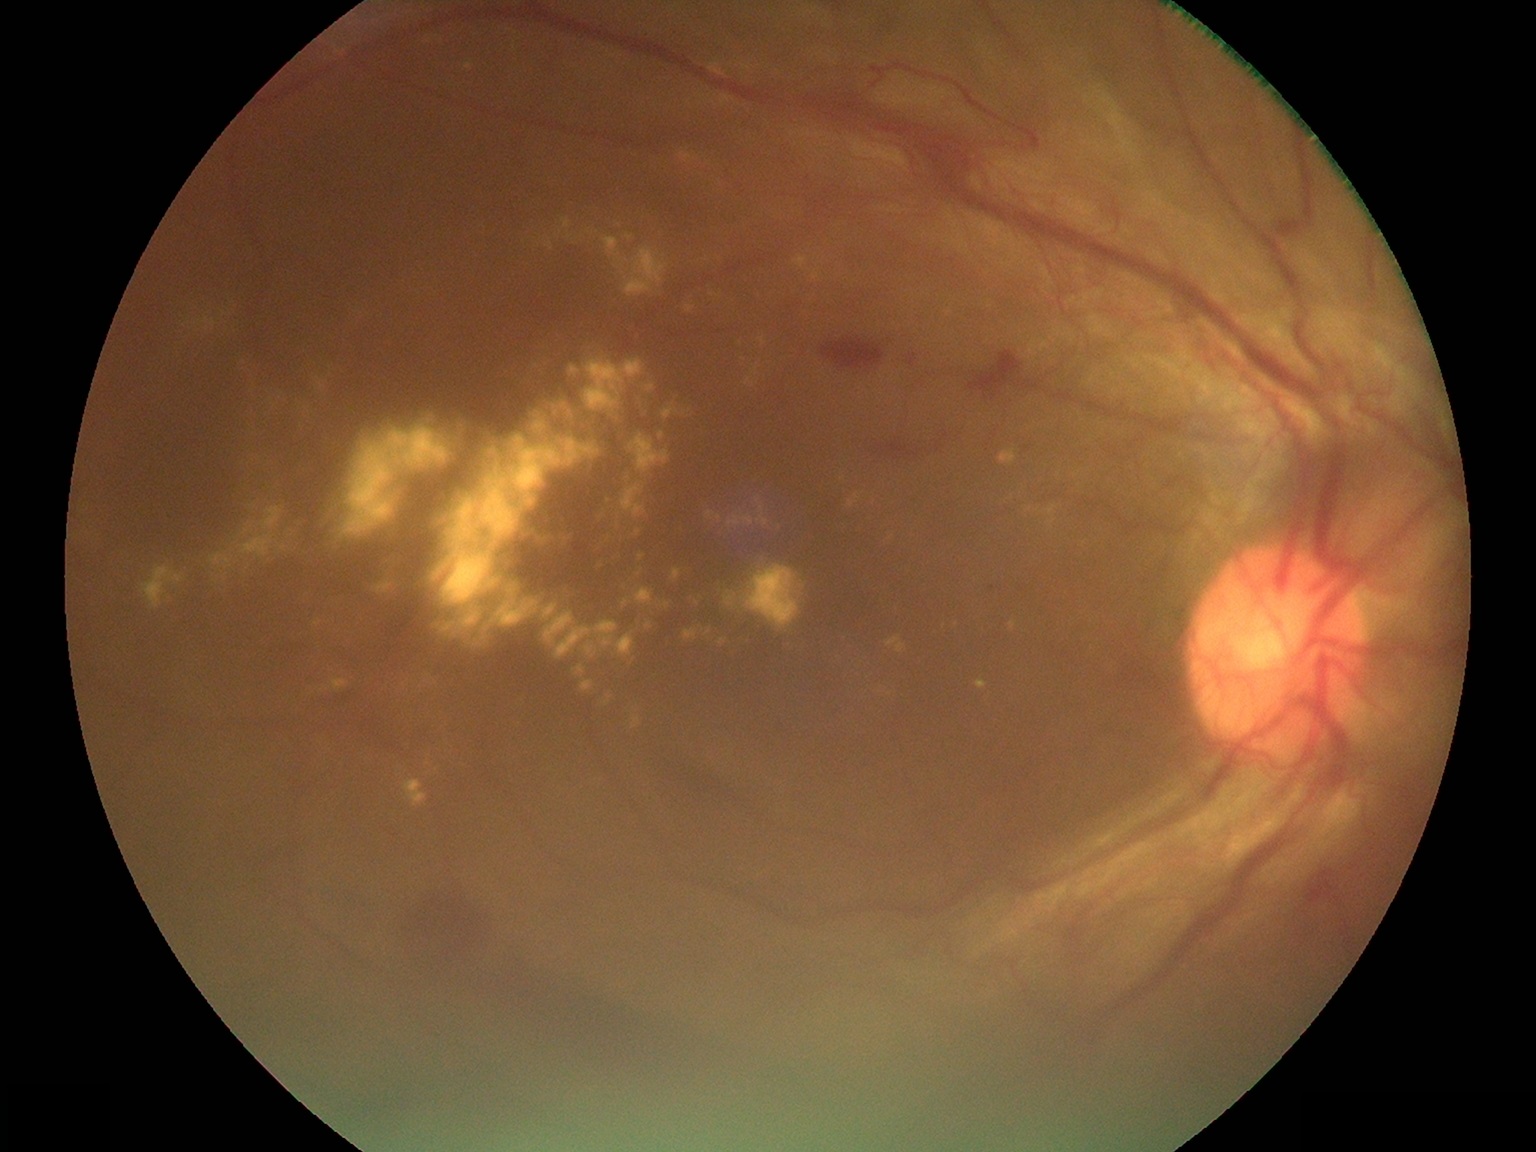

Diabetic retinopathy (DR) is proliferative diabetic retinopathy (grade 4); proliferative diabetic retinopathy
Selected lesions:
hemorrhages (HEs): left=822, top=337, right=885, bottom=370, left=1305, top=868, right=1339, bottom=904, left=913, top=139, right=979, bottom=182, left=968, top=351, right=1023, bottom=401, left=878, top=439, right=937, bottom=457, left=498, top=964, right=790, bottom=1096, left=408, top=894, right=492, bottom=978, left=904, top=354, right=918, bottom=368, left=1277, top=220, right=1302, bottom=238
Small HEs near point(1275, 239)
hard exudates (EXs) (more not shown): left=585, top=641, right=599, bottom=659, left=424, top=673, right=438, bottom=684, left=194, top=311, right=218, bottom=332, left=640, top=395, right=647, bottom=412, left=141, top=566, right=186, bottom=610, left=662, top=403, right=680, bottom=421, left=710, top=292, right=721, bottom=298, left=432, top=435, right=603, bottom=639, left=435, top=523, right=450, bottom=529, left=474, top=639, right=481, bottom=647, left=457, top=424, right=470, bottom=432, left=724, top=592, right=736, bottom=608
Small EXs near point(186, 325), point(244, 363), point(846, 638), point(603, 517), point(428, 764), point(191, 329), point(238, 542)
soft exudates (SEs): none
microaneurysms (MAs): none